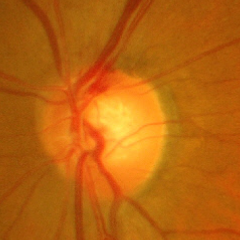

Q: What stage of glaucoma is present?
A: Advanced glaucomatous optic neuropathy.